Camera: NIDEK AFC-230 — 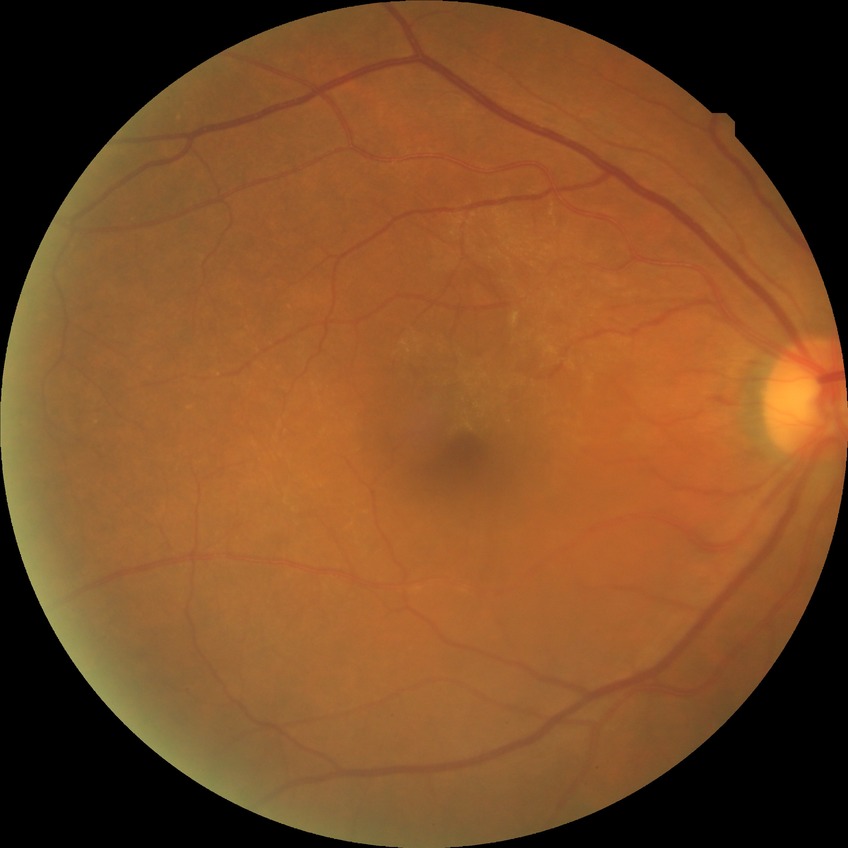
Diabetic retinopathy (DR) is no diabetic retinopathy (NDR).